Camera: Remidio FOP fundus camera:
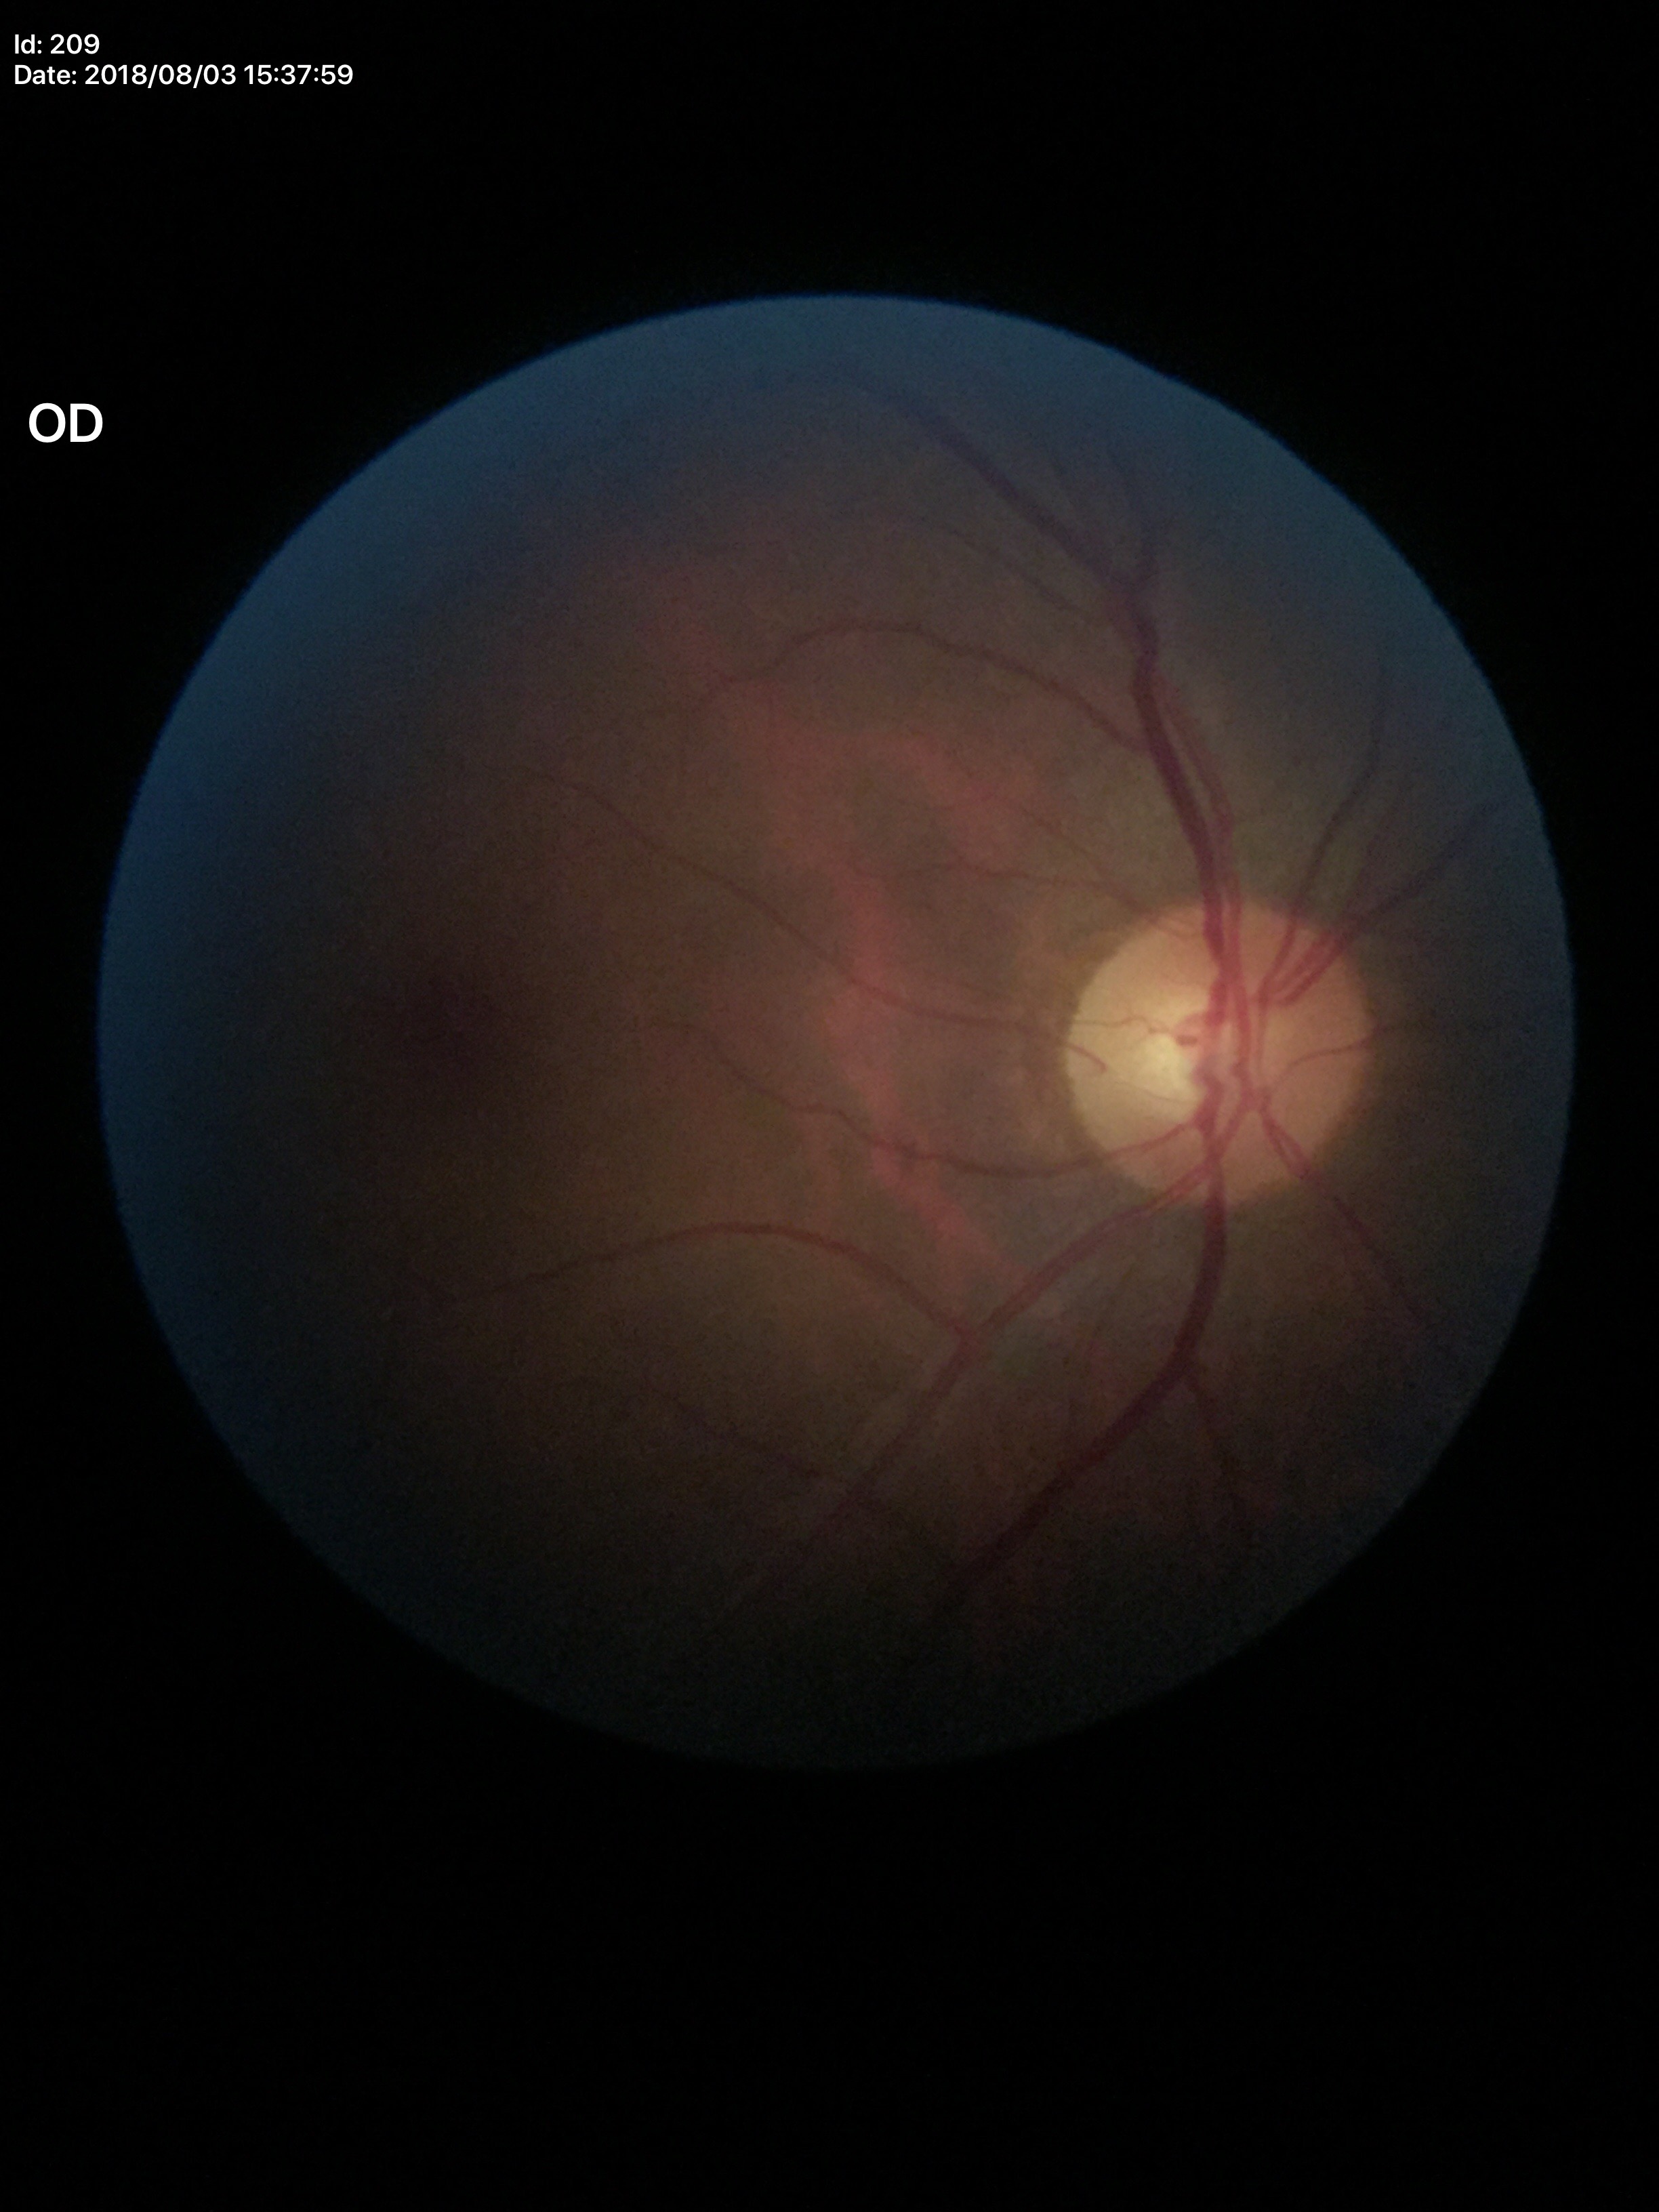

Findings:
- vertical CDR (VCDR) · 0.55
- Glaucoma decision · not suspect